Fundus image cropped to the optic disc · dilated pupil:
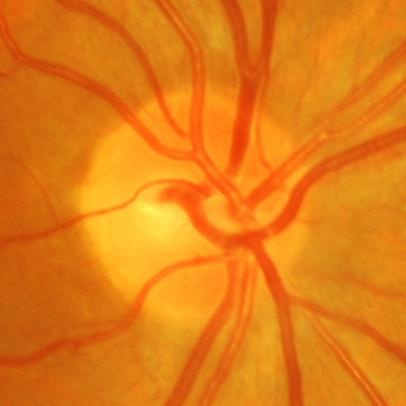

Assessment: glaucomatous optic neuropathy.